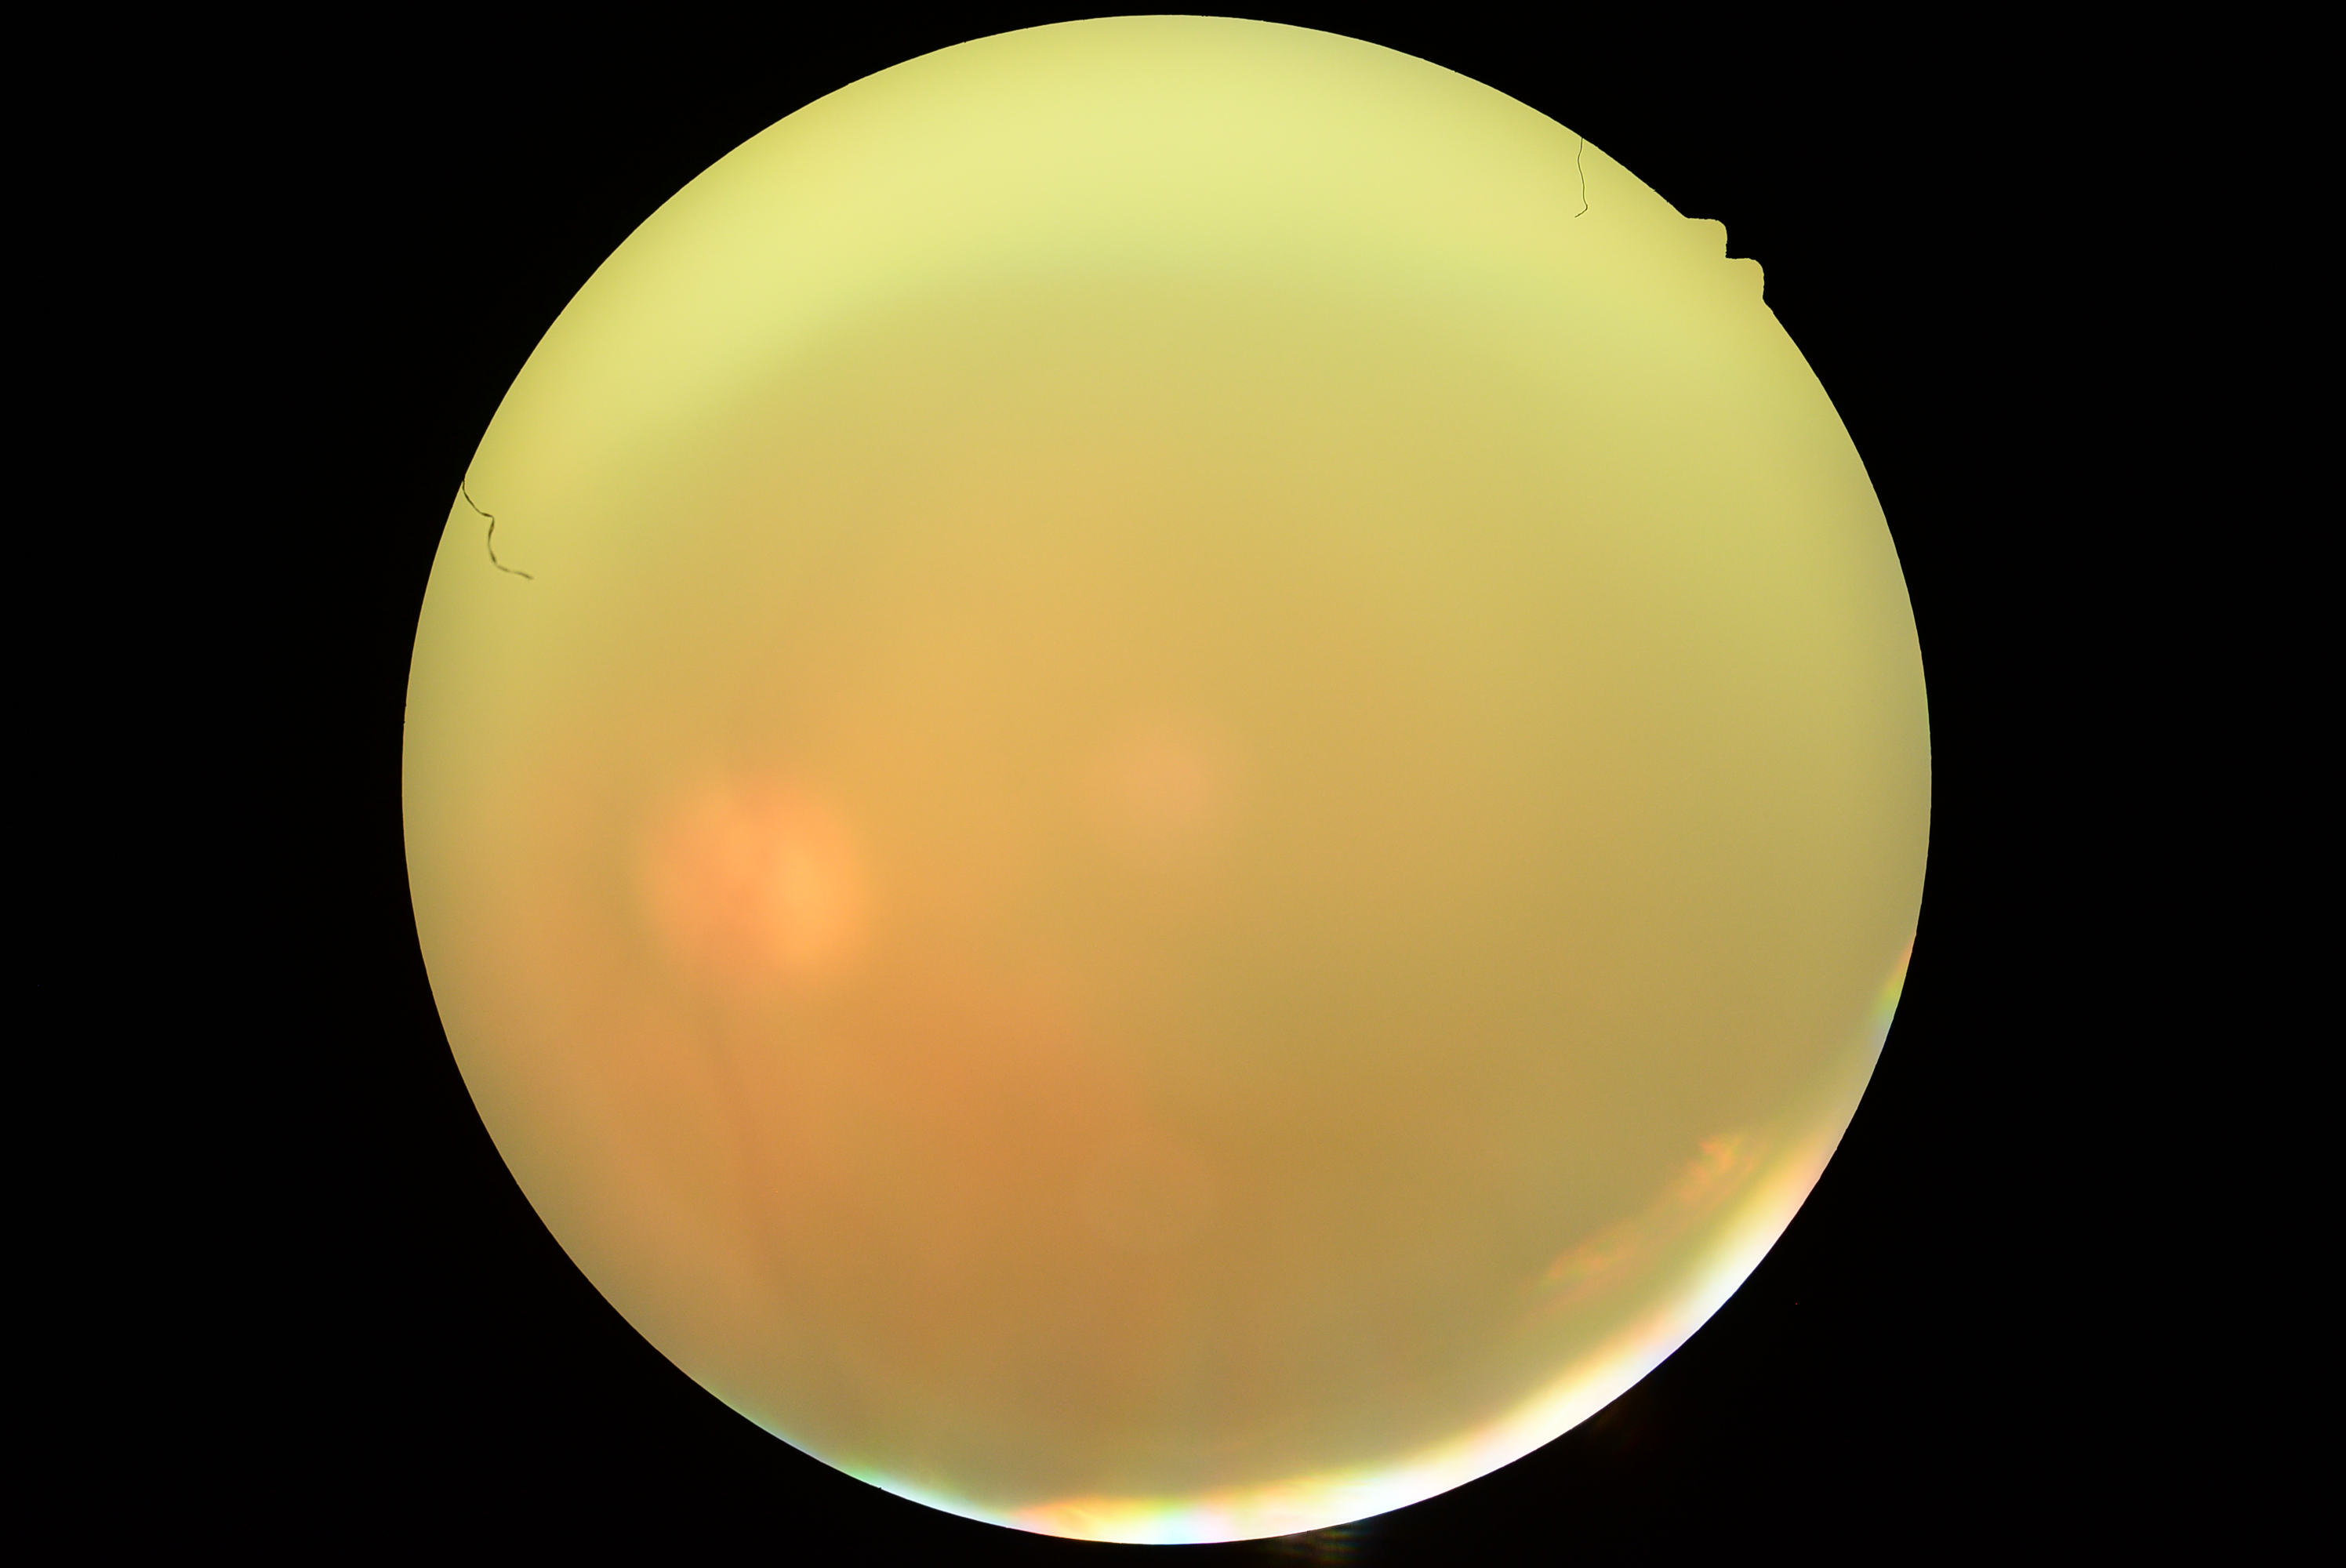
diabetic retinopathy (DR): ungradable.